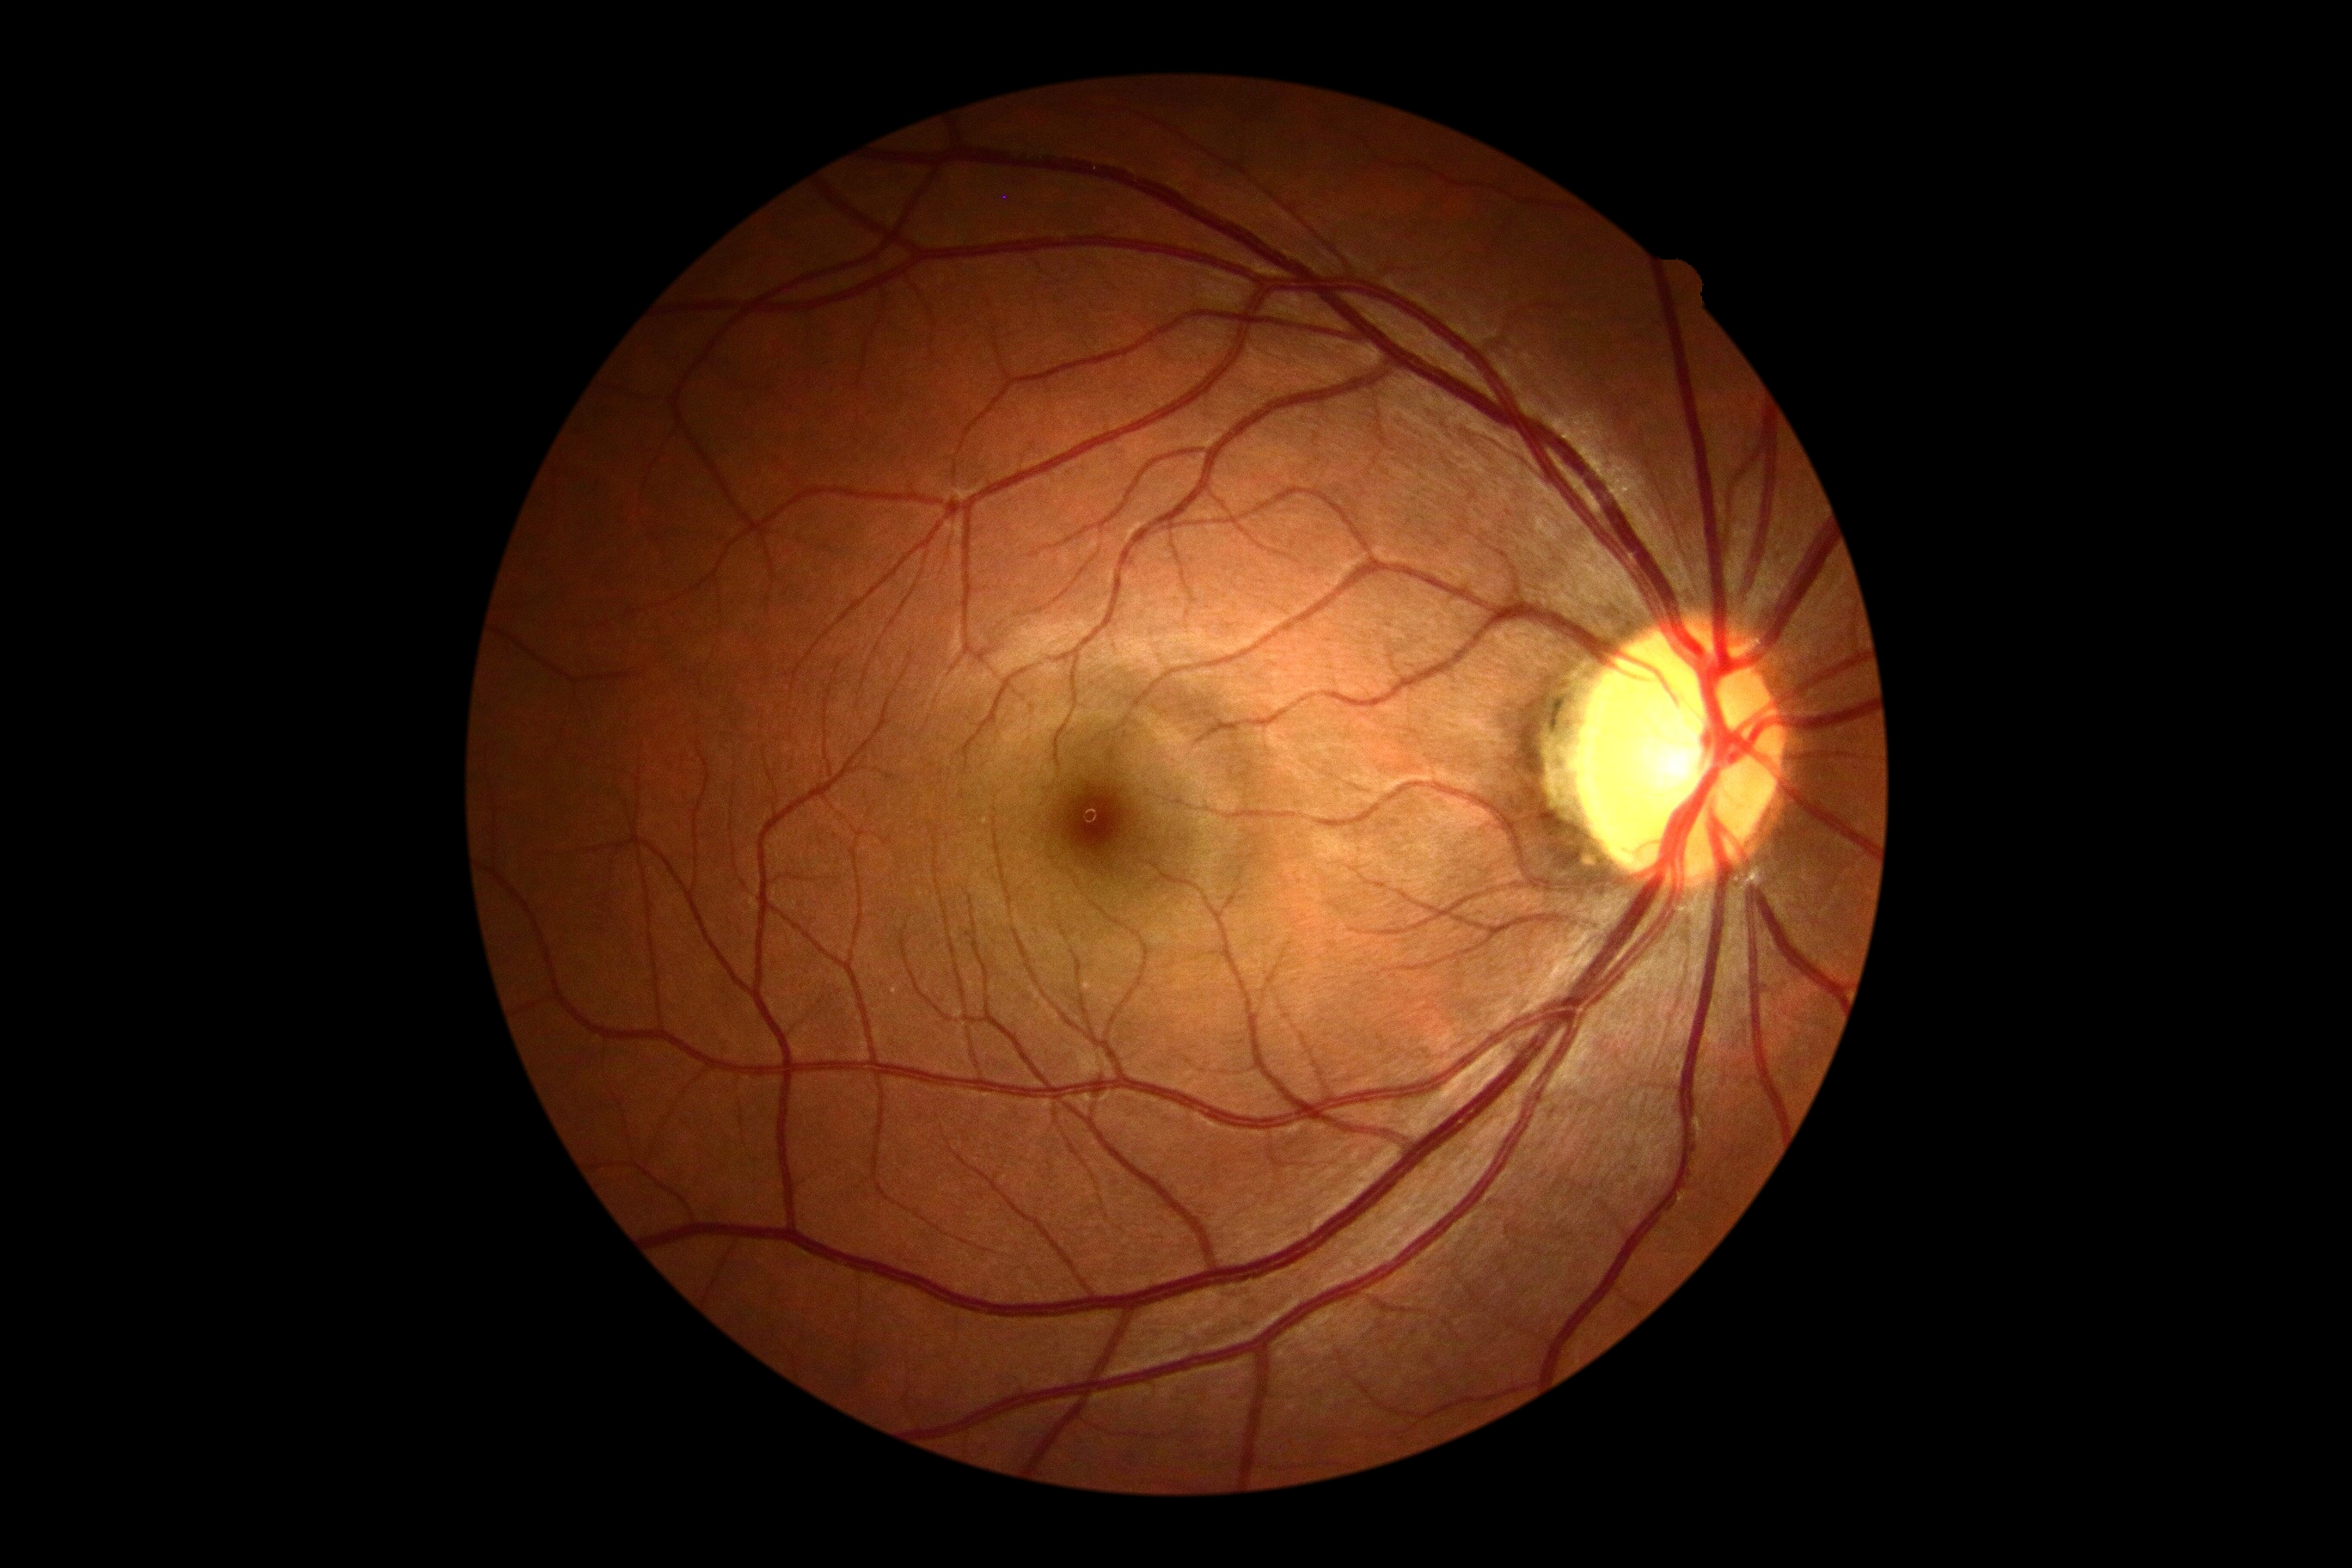

DR grade=no apparent diabetic retinopathy (0) — no visible signs of diabetic retinopathy.